848x848px — 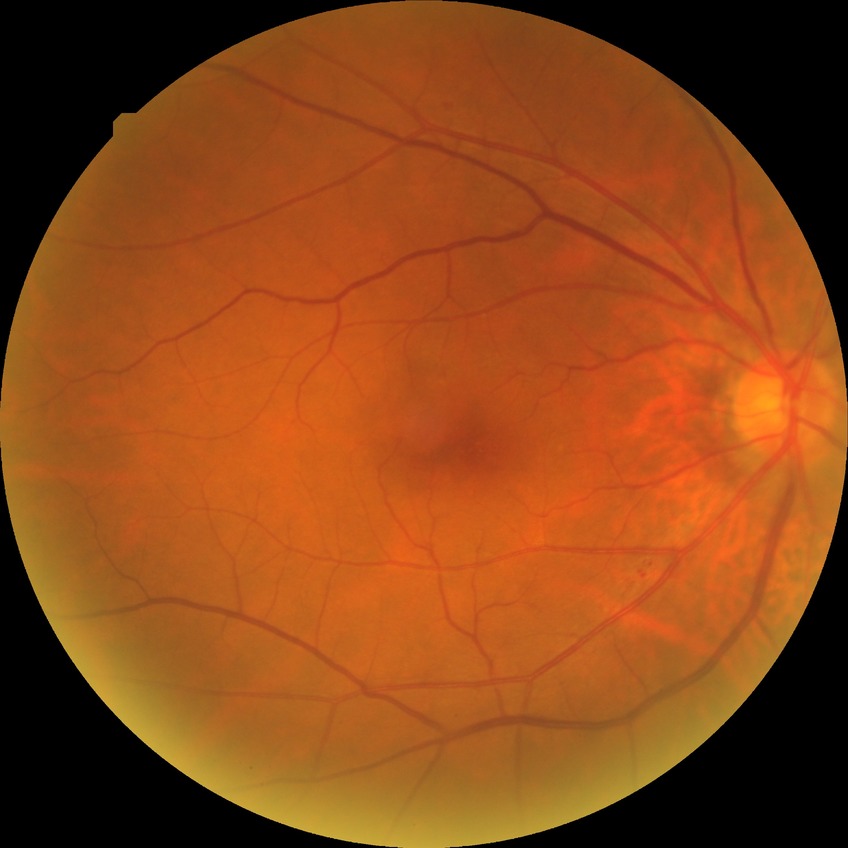
Diabetic retinopathy (DR): NDR (no diabetic retinopathy).